Color fundus image
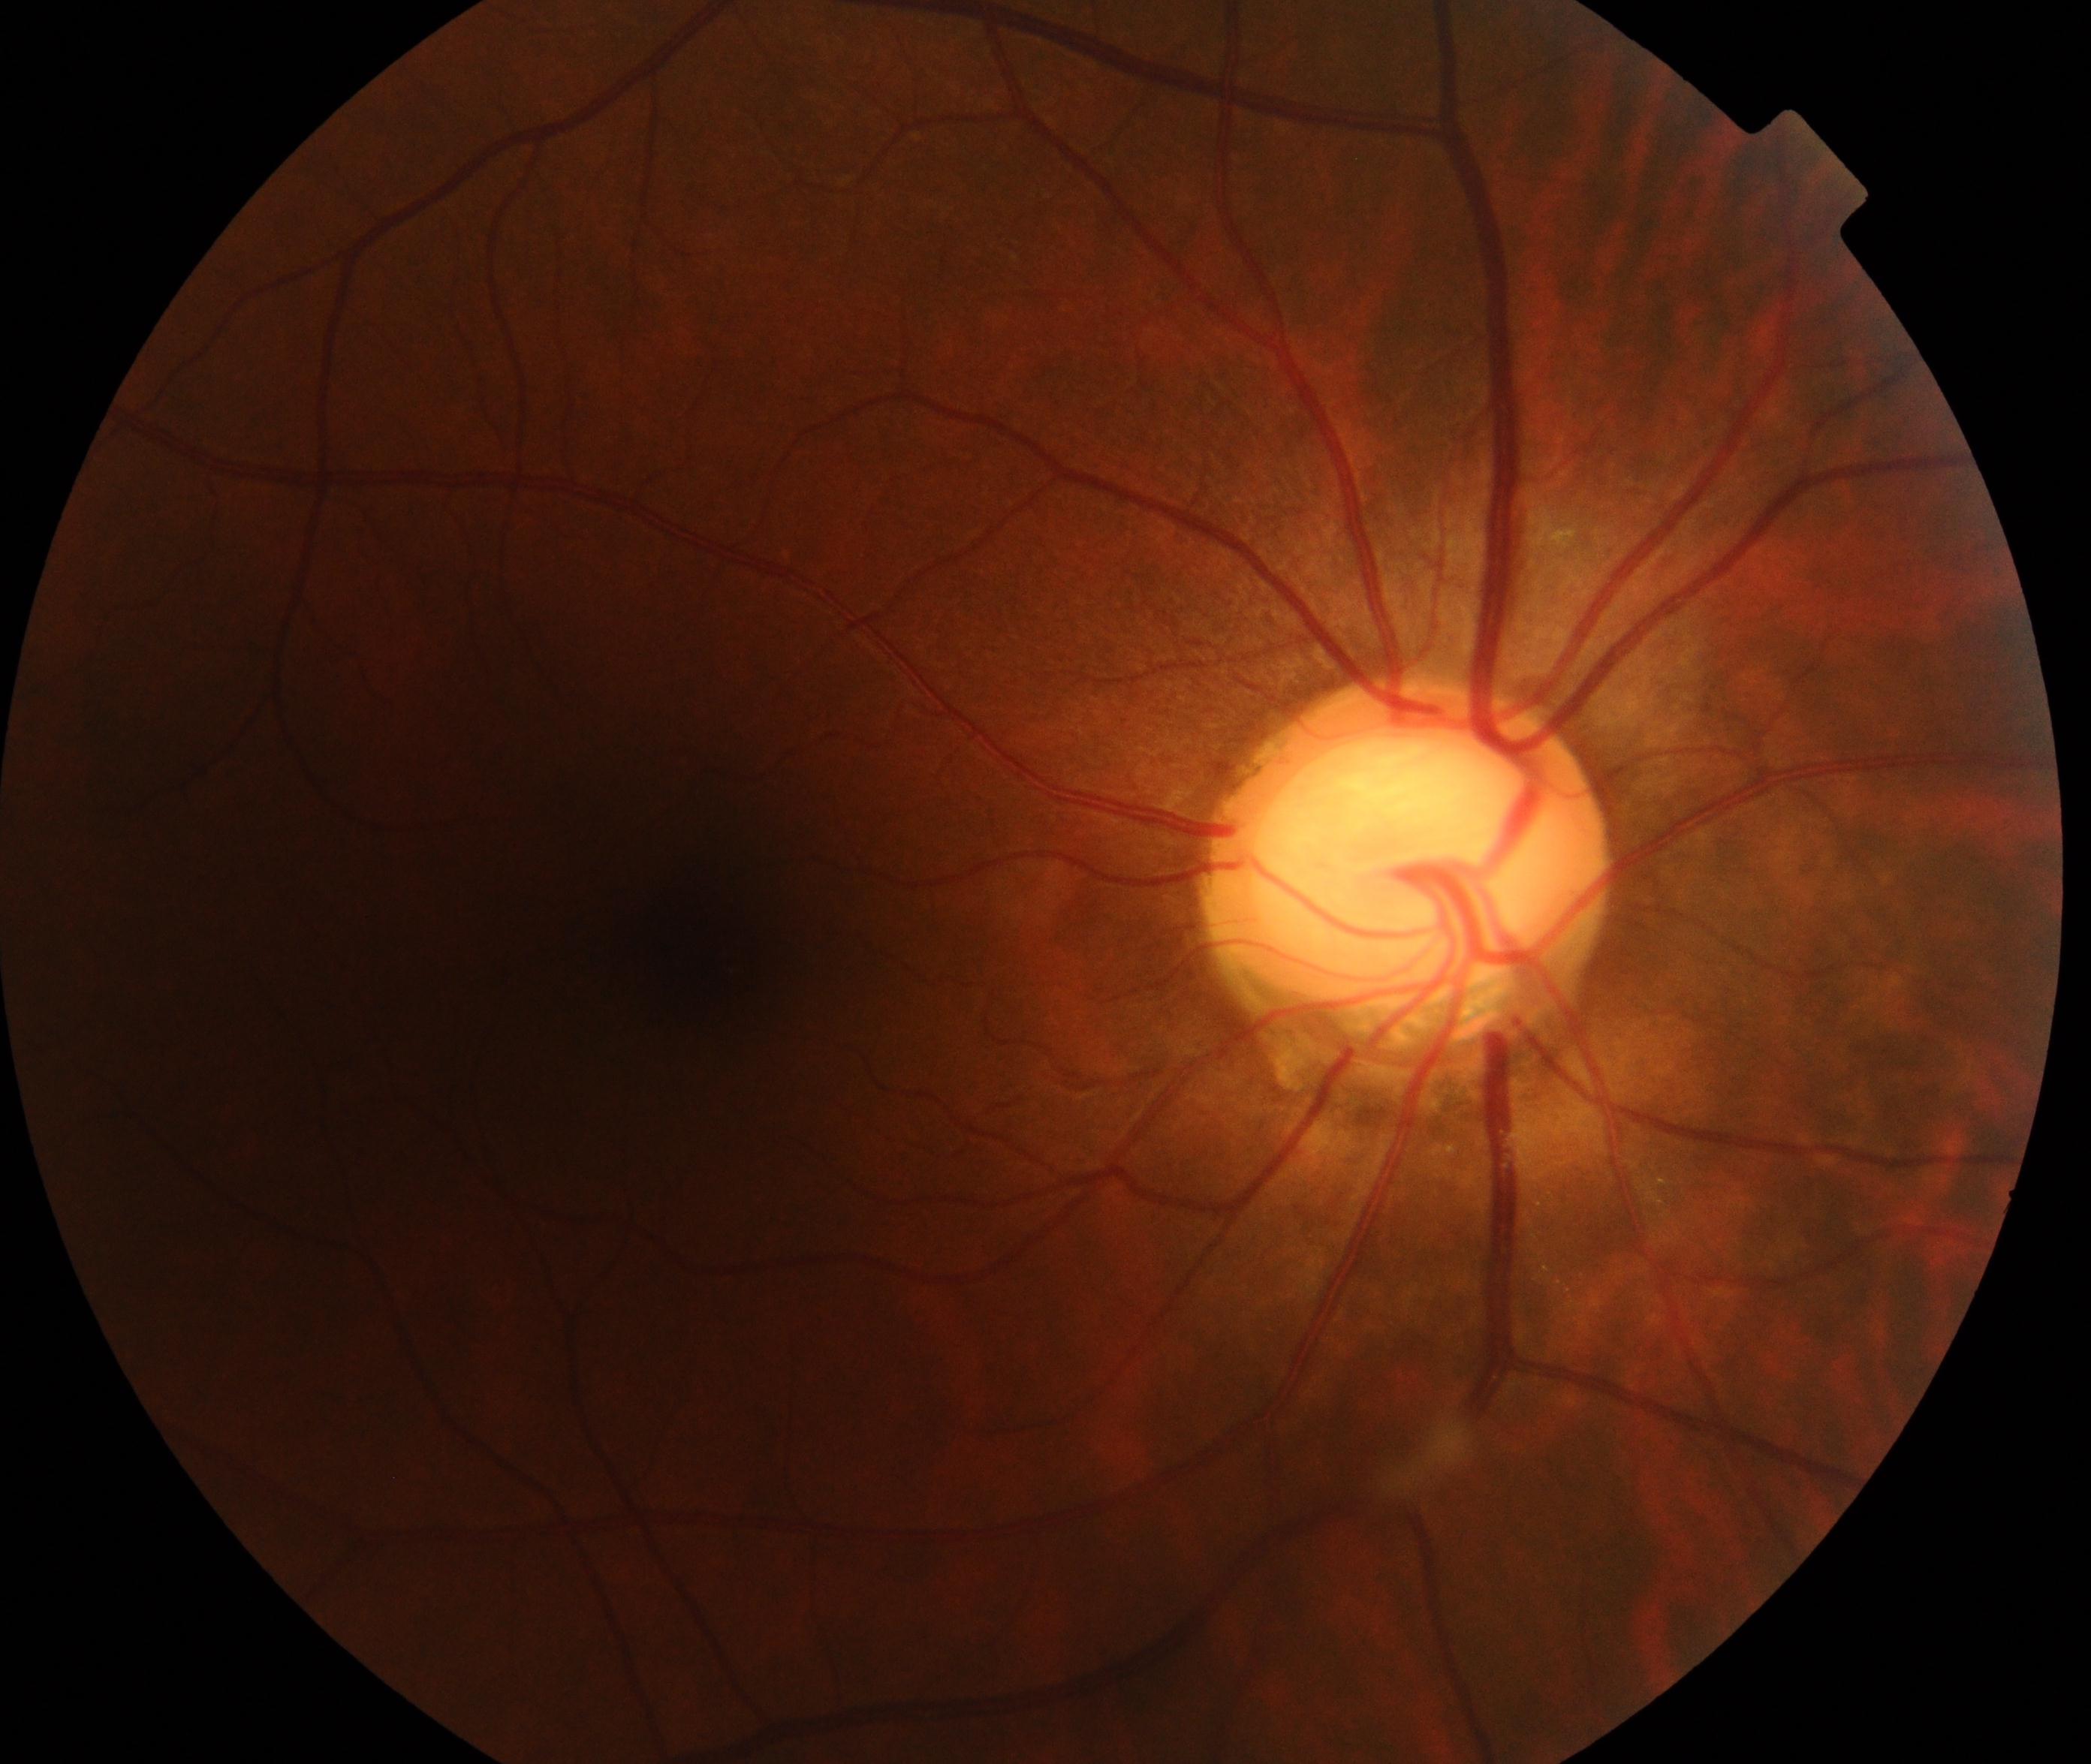 Findings consistent with possible glaucoma. Defined by large cup-to-disc ratio with cup excavation, thinning of the neuroretinal rim, notching and bayoneting of vessels with retinal nerve fiber layer defects, disc hemorrhages, baring of circumlinear blood vessels, laminar dot sign, or peripapillary atrophy.